Image size 640x480. Clarity RetCam 3, 130° FOV. Pediatric retinal photograph (wide-field):
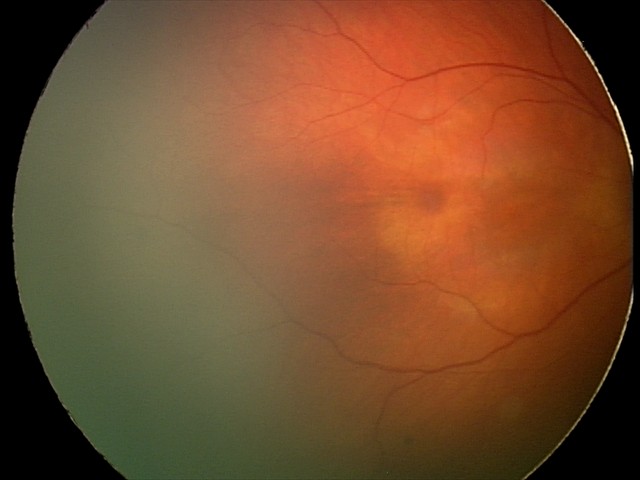
From an examination with diagnosis of retinal hemorrhages.